640x480. Pediatric wide-field fundus photograph:
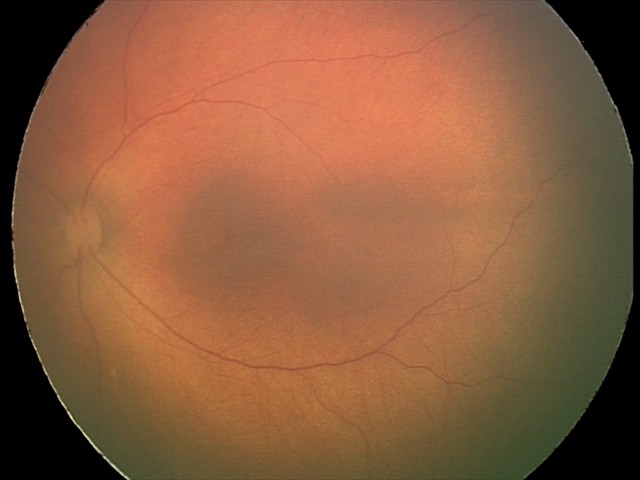
Screening diagnosis: normal retinal appearance.